640 by 480 pixels; infant wide-field fundus photograph; 130° field of view (Clarity RetCam 3):
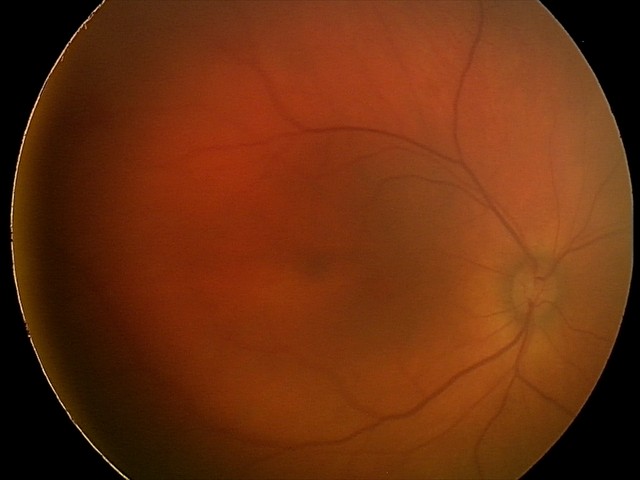
Series diagnosed as retinal hemorrhages.